Wide-field contact fundus photograph of an infant: 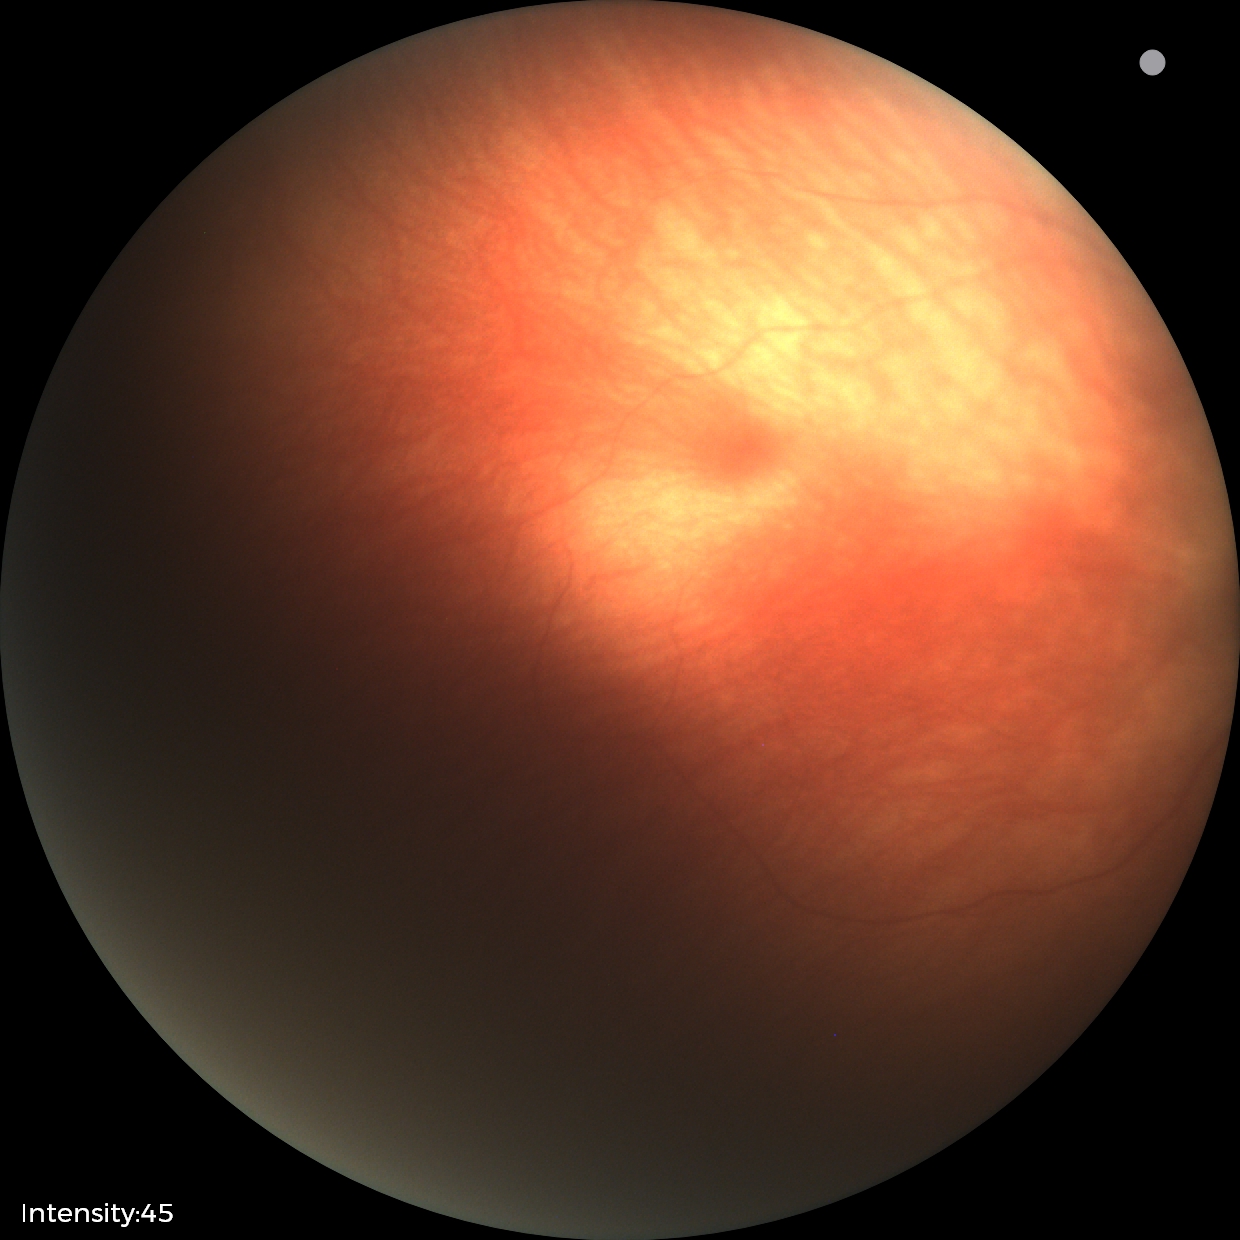

Assessment: physiological appearance with no retinal pathology.